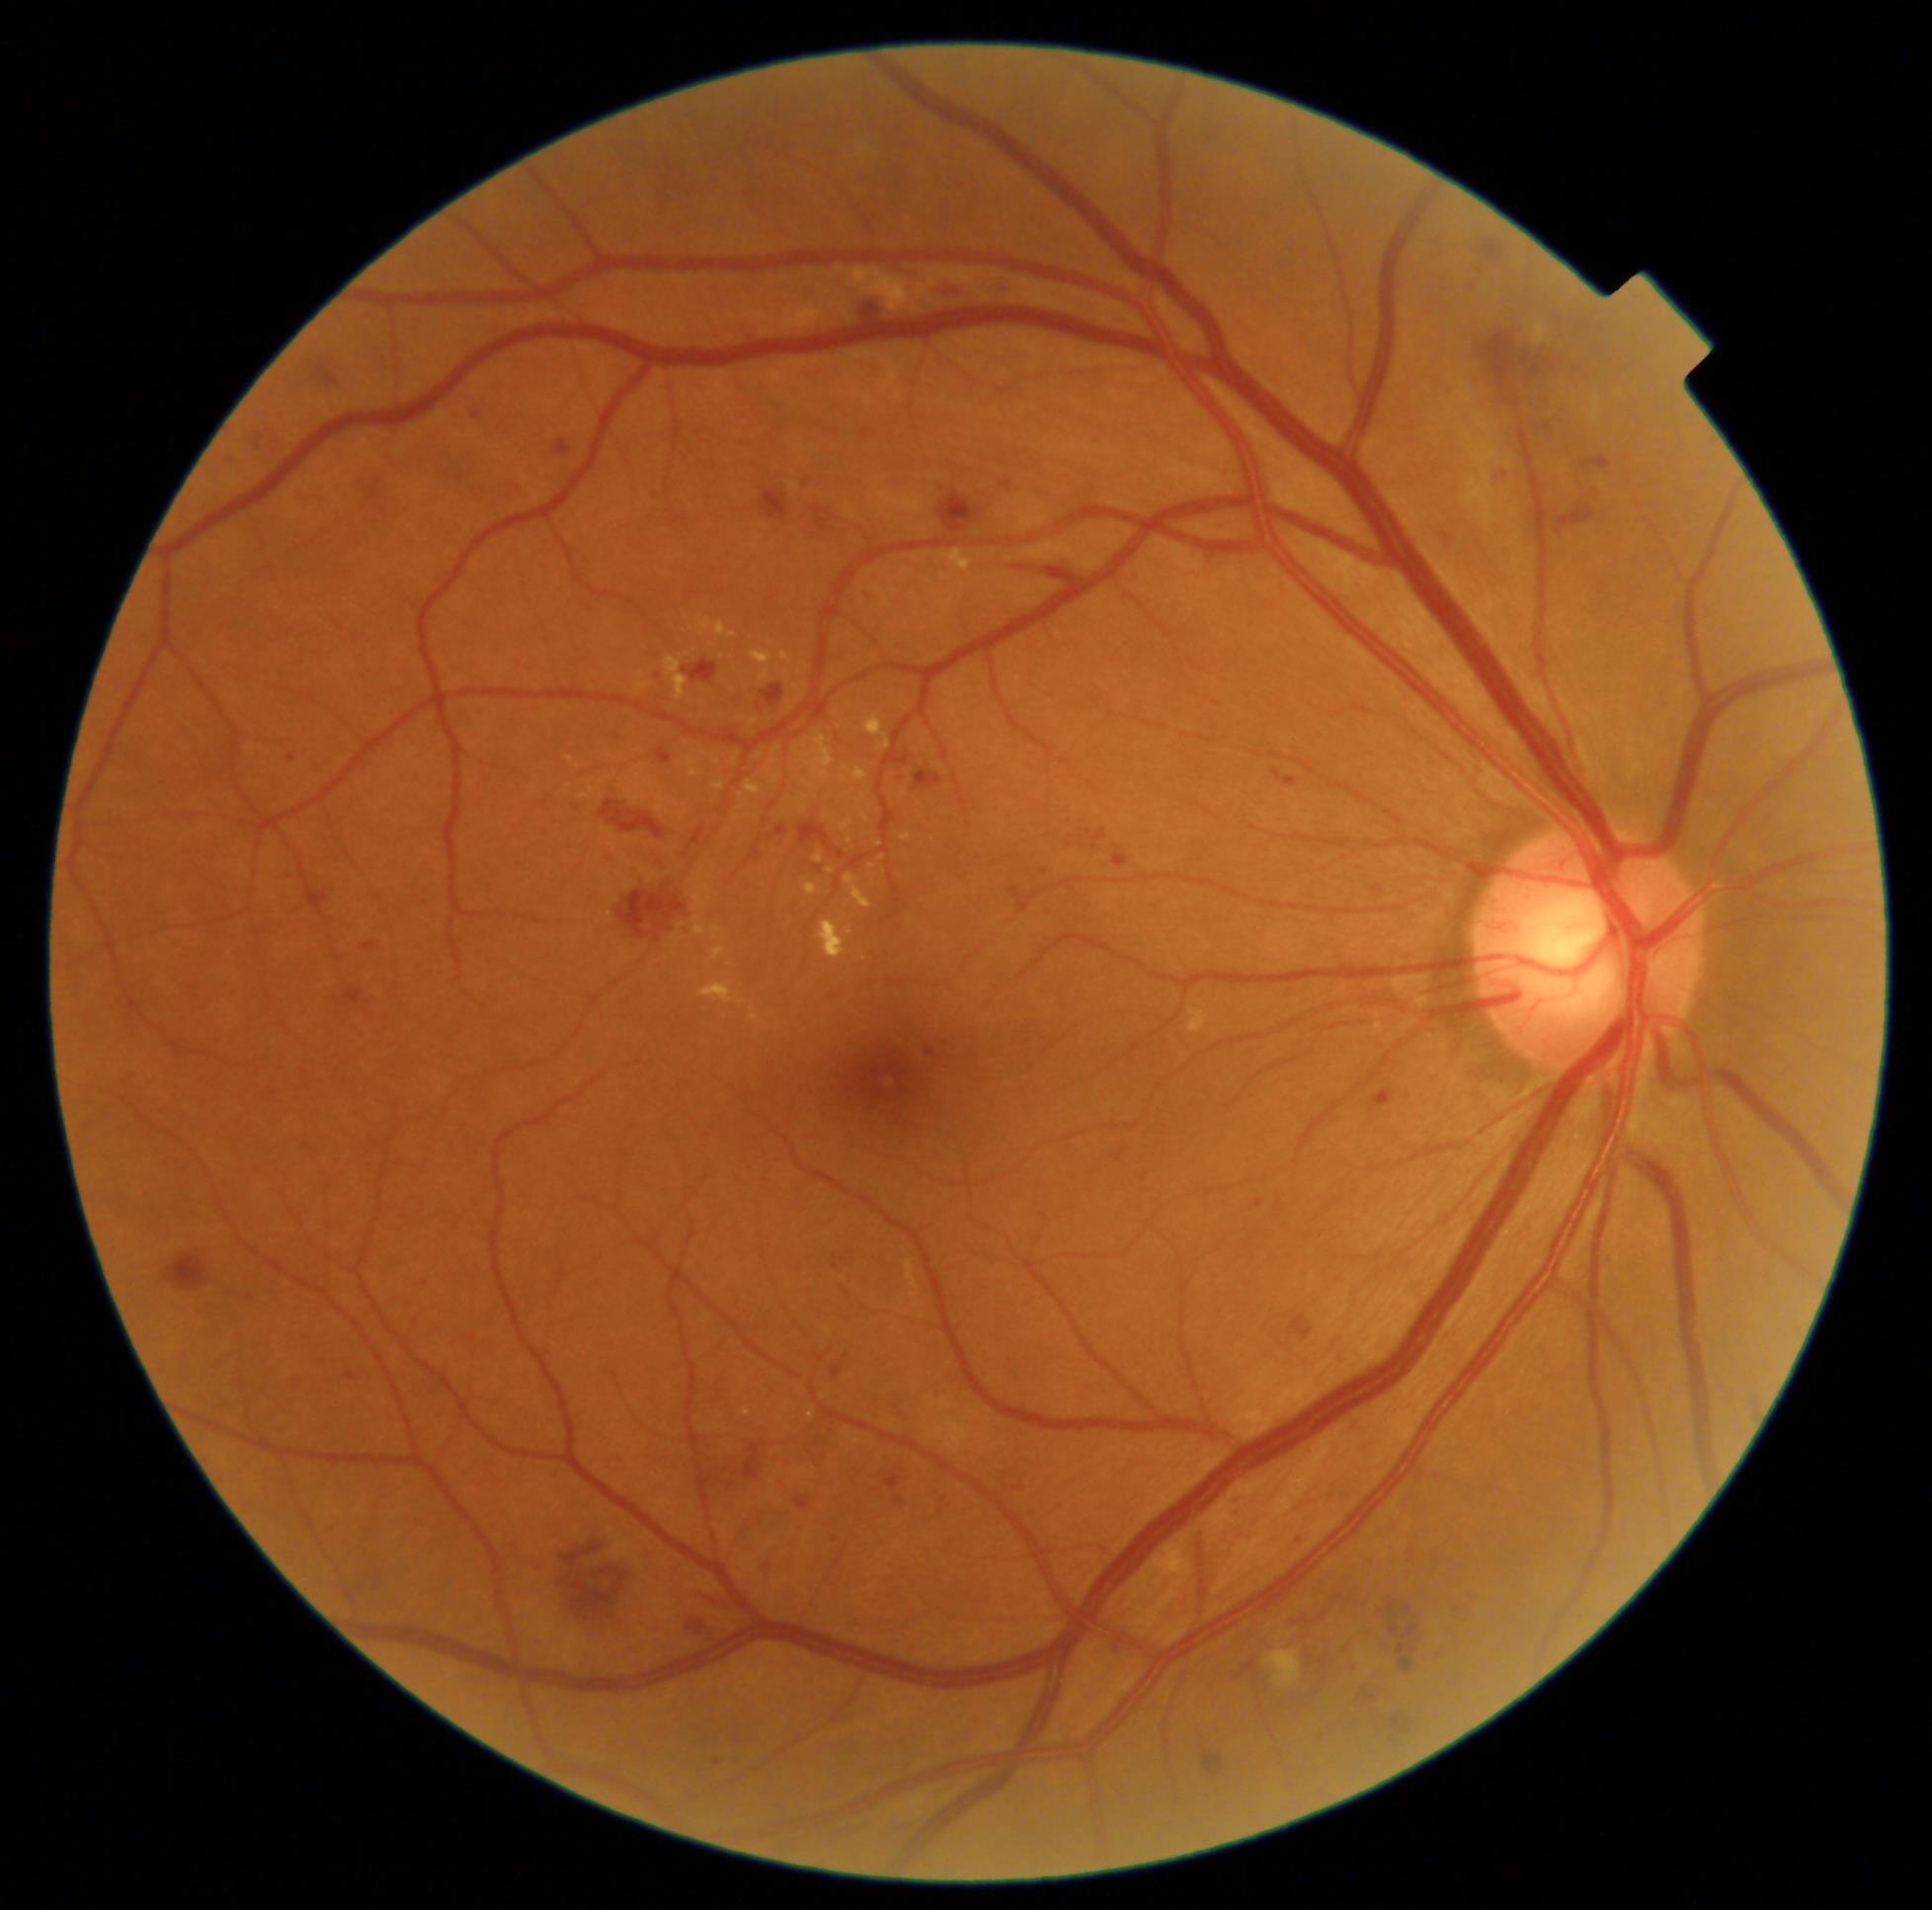

diabetic retinopathy severity: grade 2 (moderate NPDR), DR class: non-proliferative diabetic retinopathy.